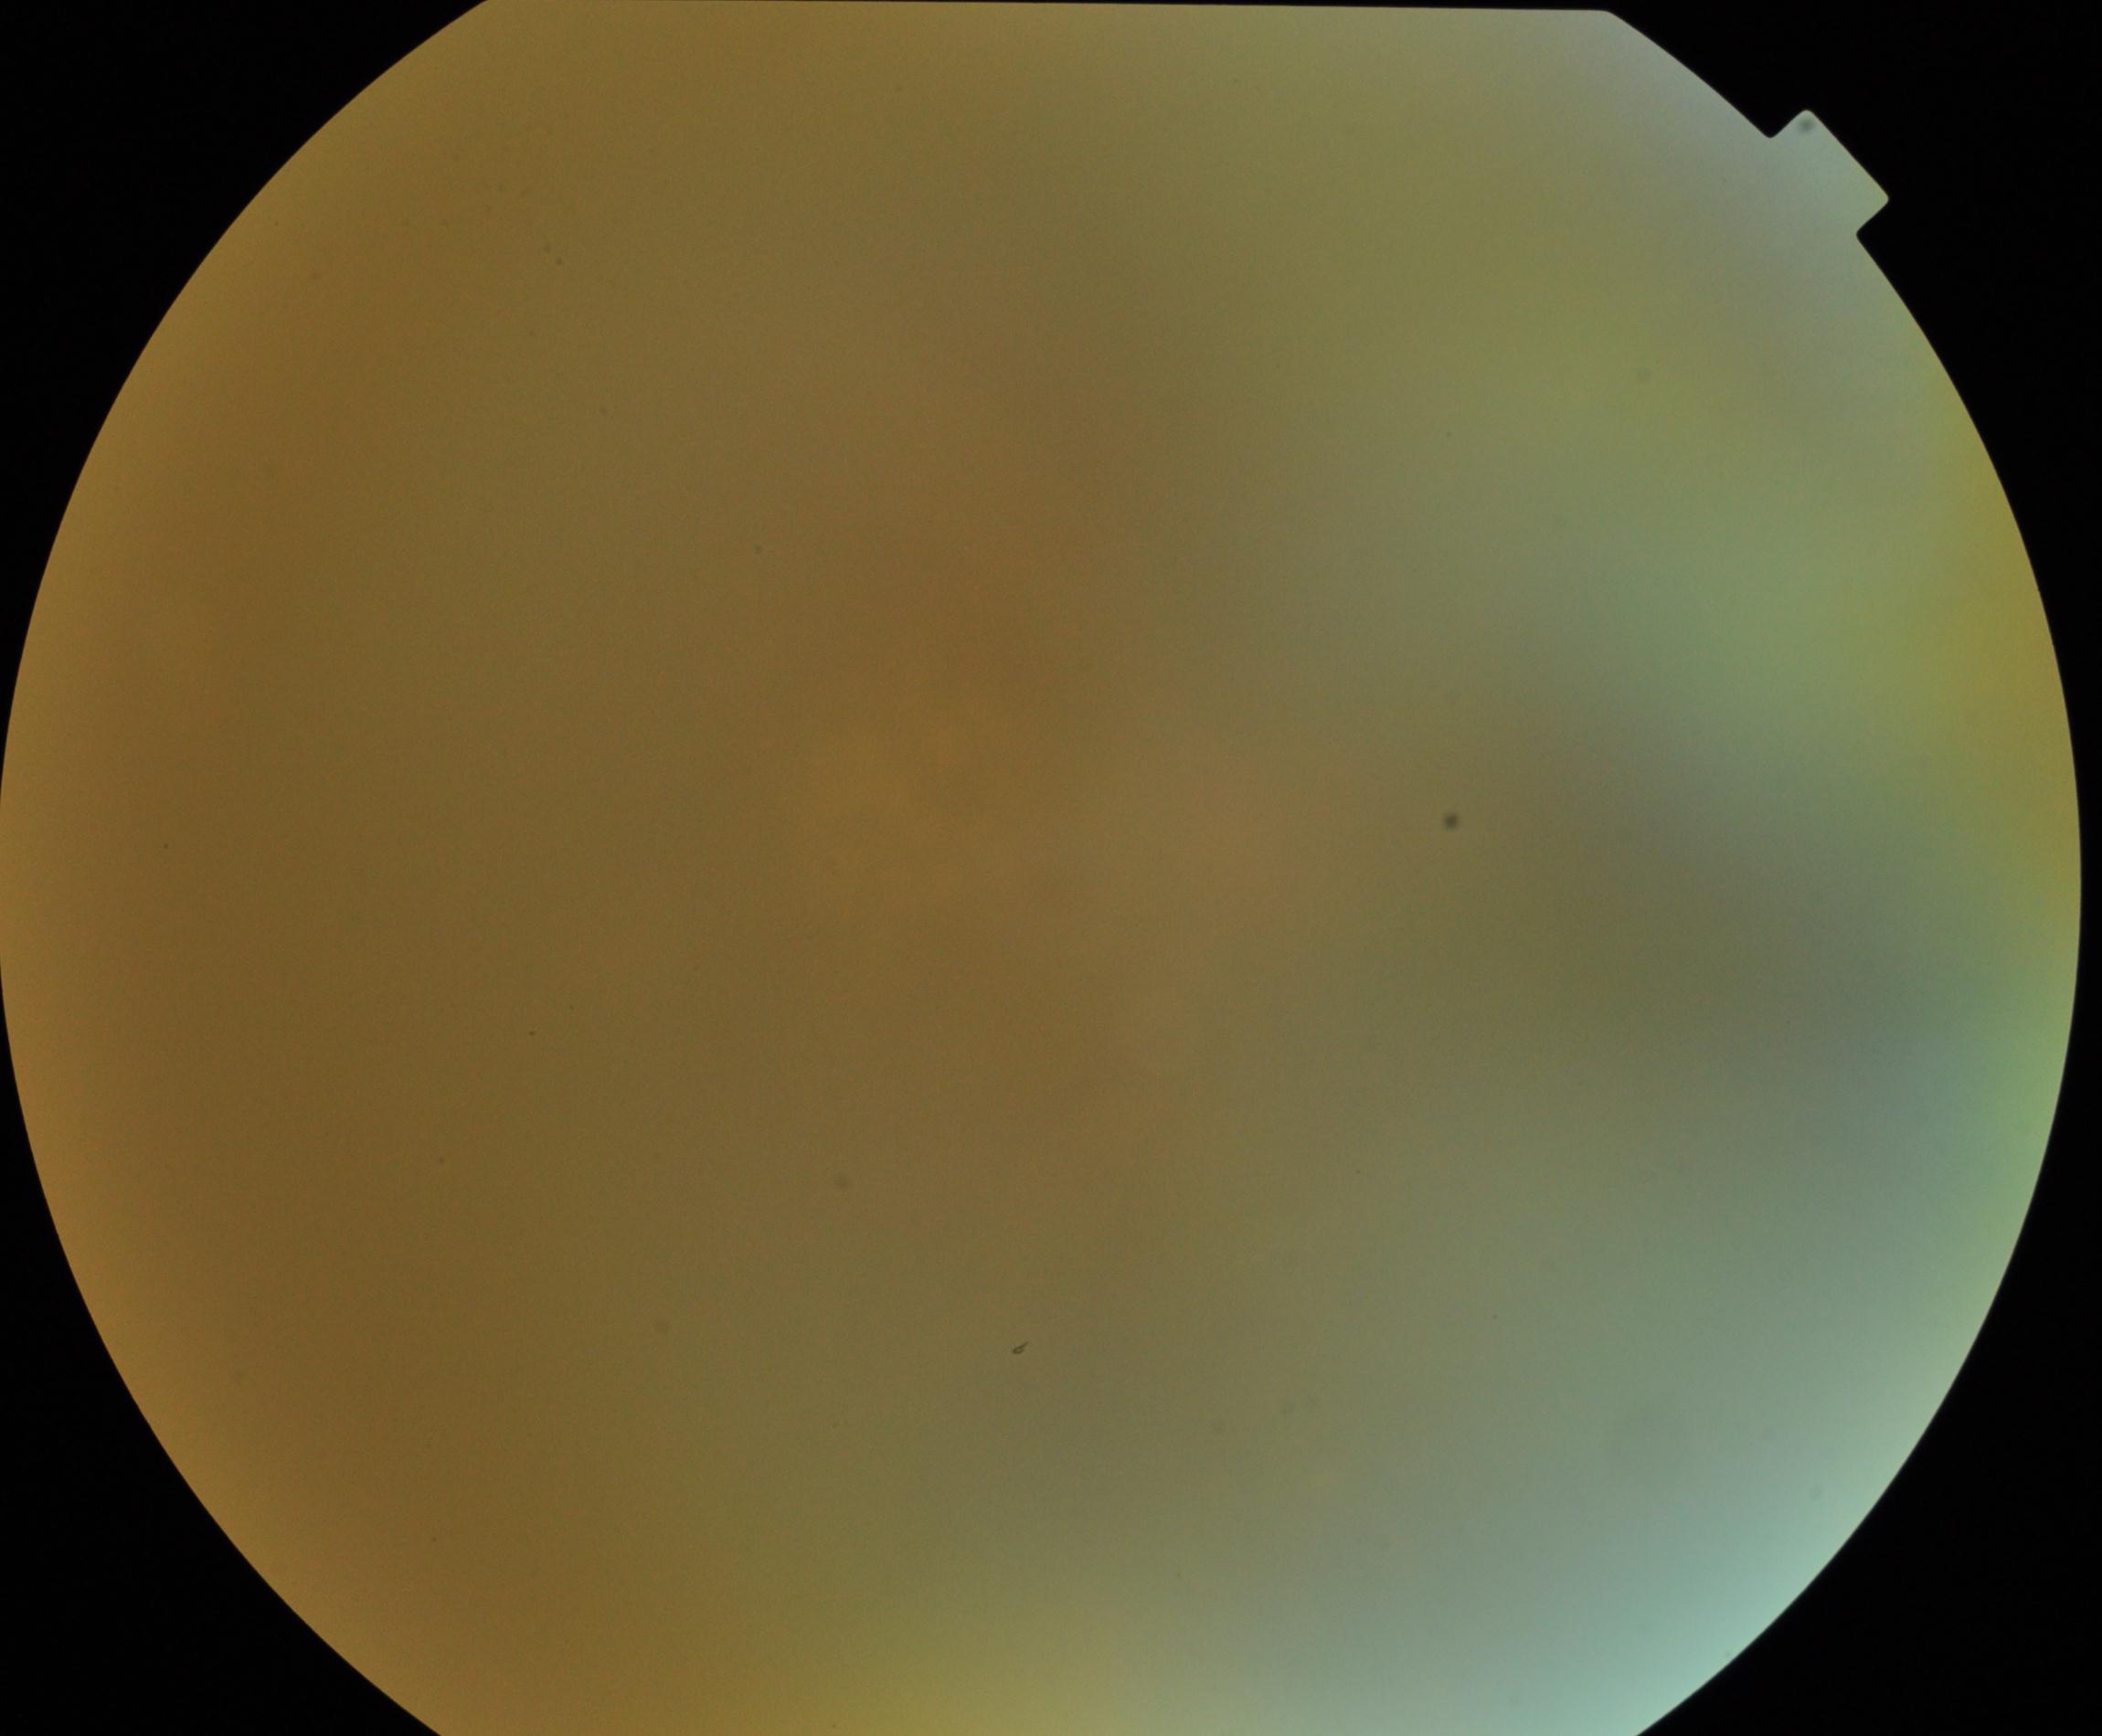 Quality: poor.
Proliferative retinopathy: absent.